Color fundus image:
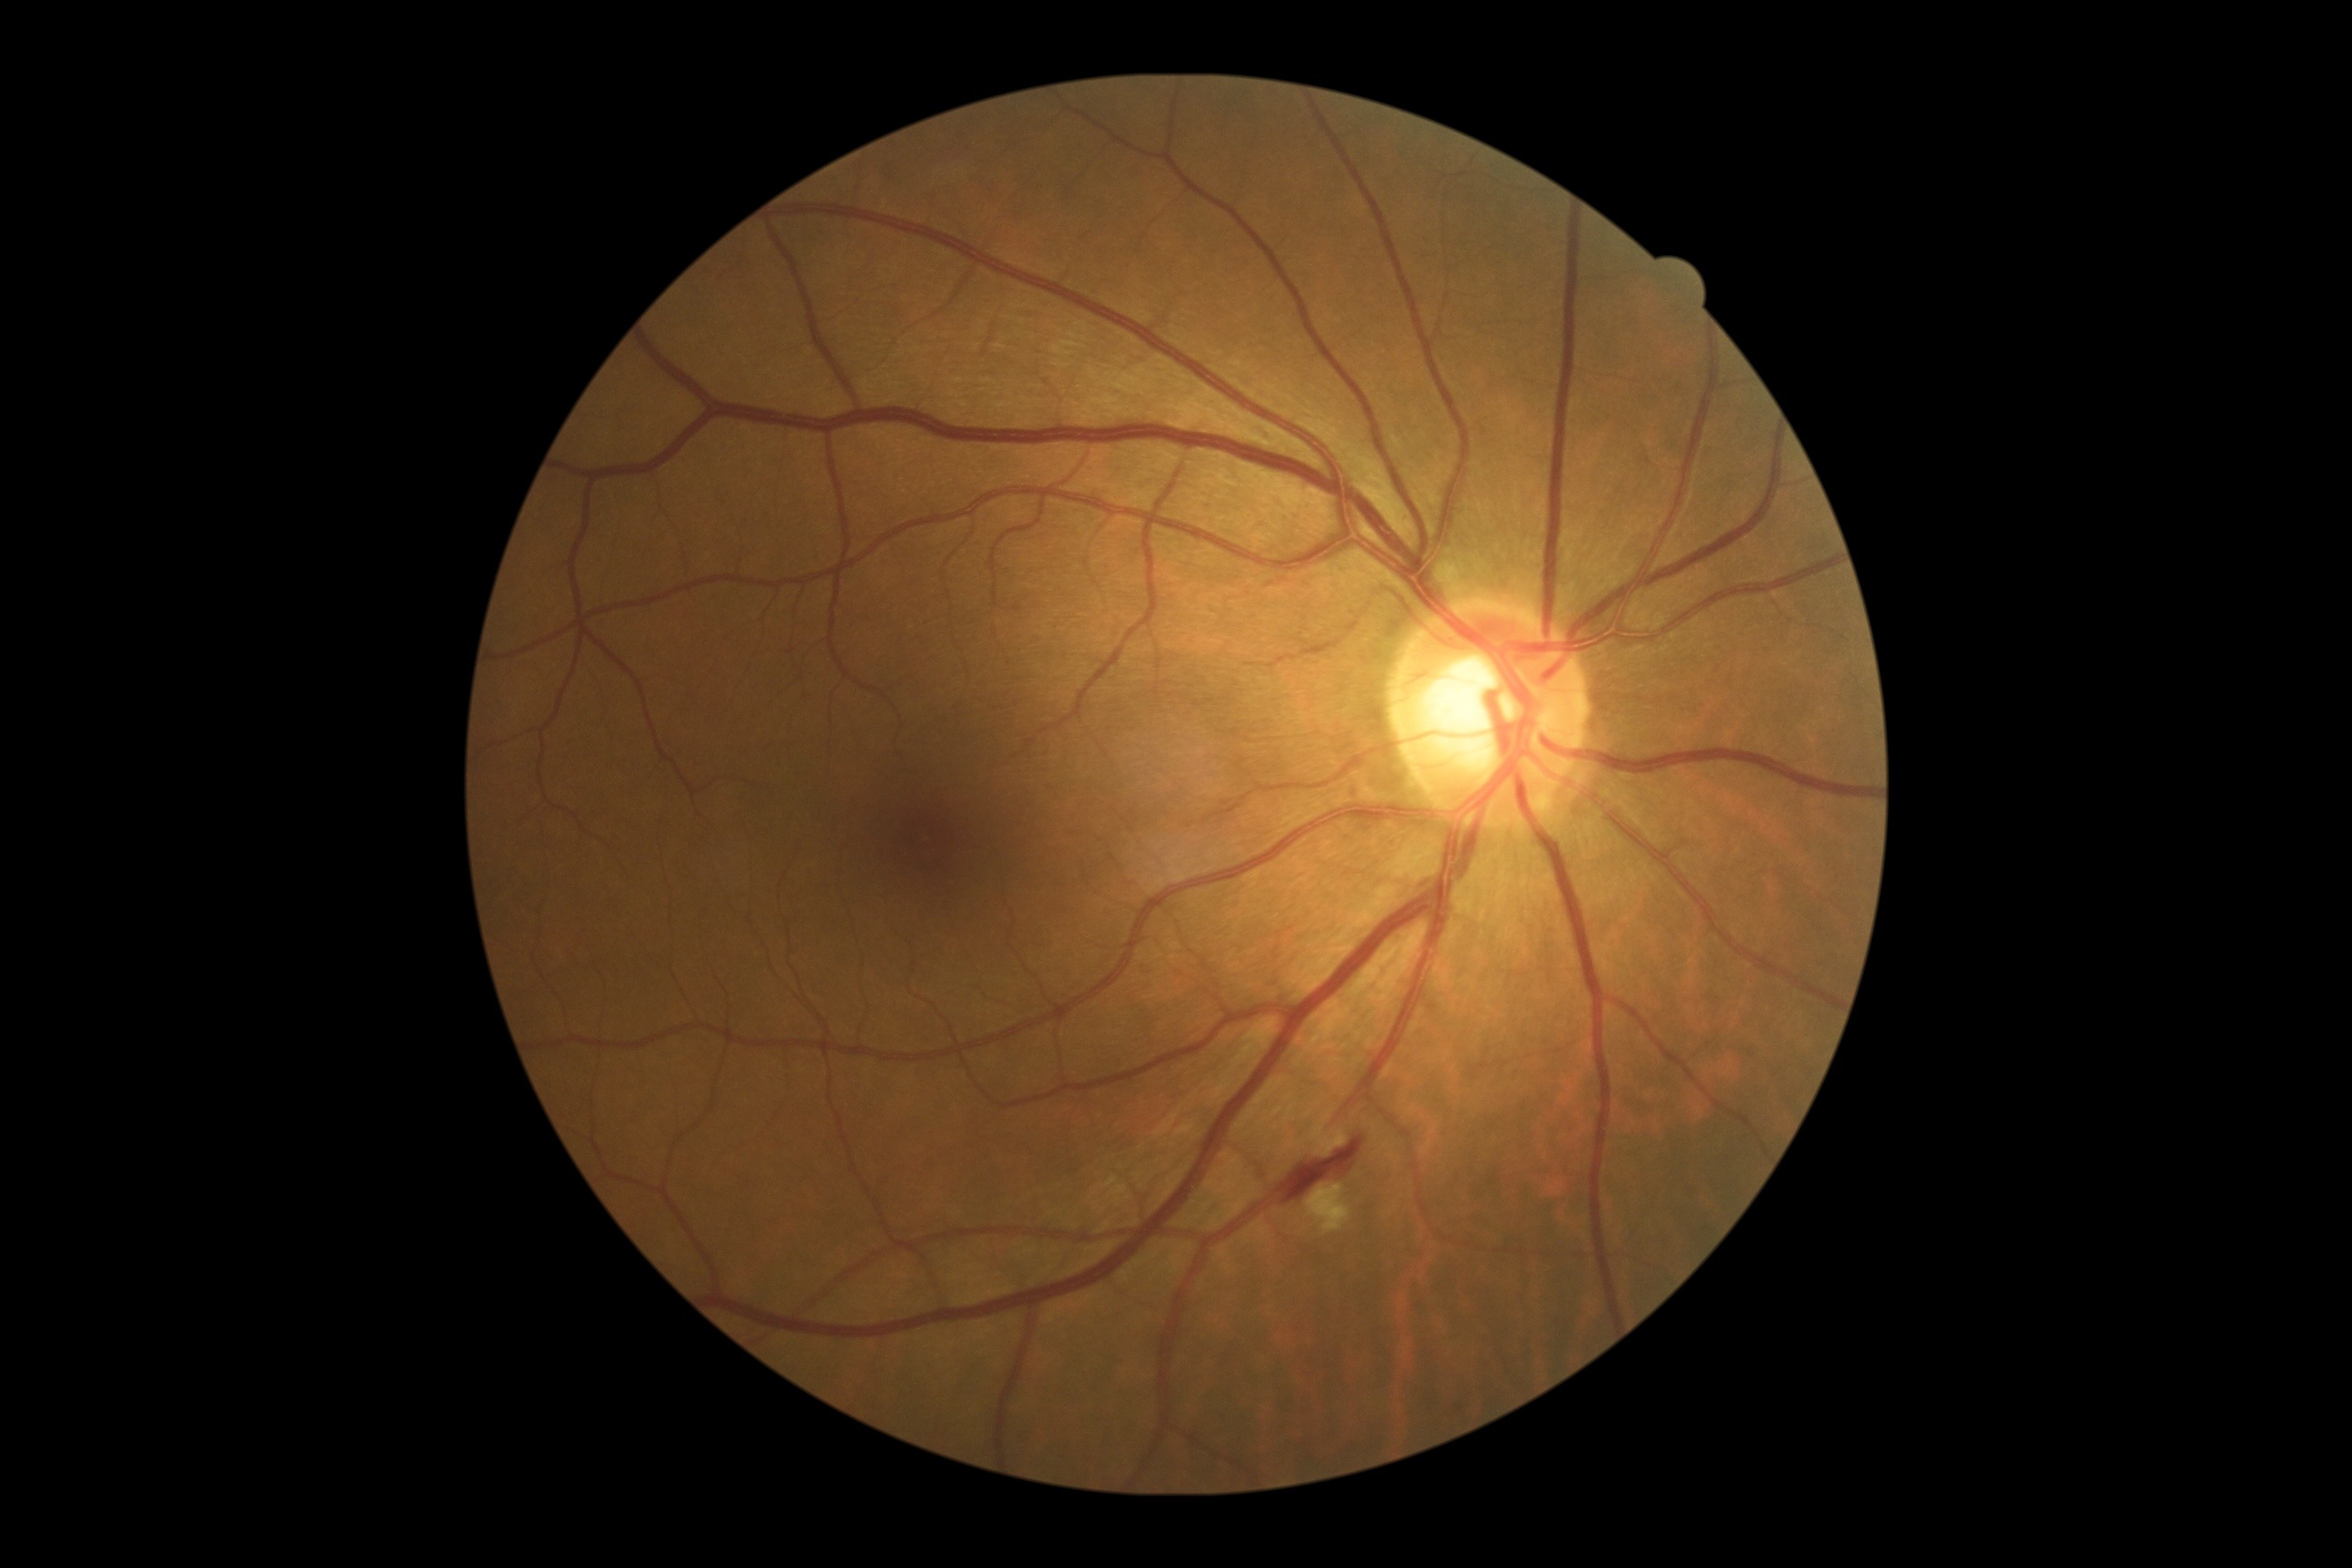

<lesions>
  <dr_grade>2</dr_grade>
  <ma>bbox=[1348, 789, 1362, 798]</ma>
  <he>bbox=[1456, 1406, 1465, 1416], bbox=[1146, 986, 1152, 994], bbox=[1141, 968, 1152, 977], bbox=[1279, 1137, 1364, 1202]</he>
  <se />
  <ex>bbox=[1306, 1184, 1353, 1237], bbox=[1317, 1130, 1348, 1157]</ex>
</lesions>